Nonmydriatic, modified Davis grading, fundus photo — 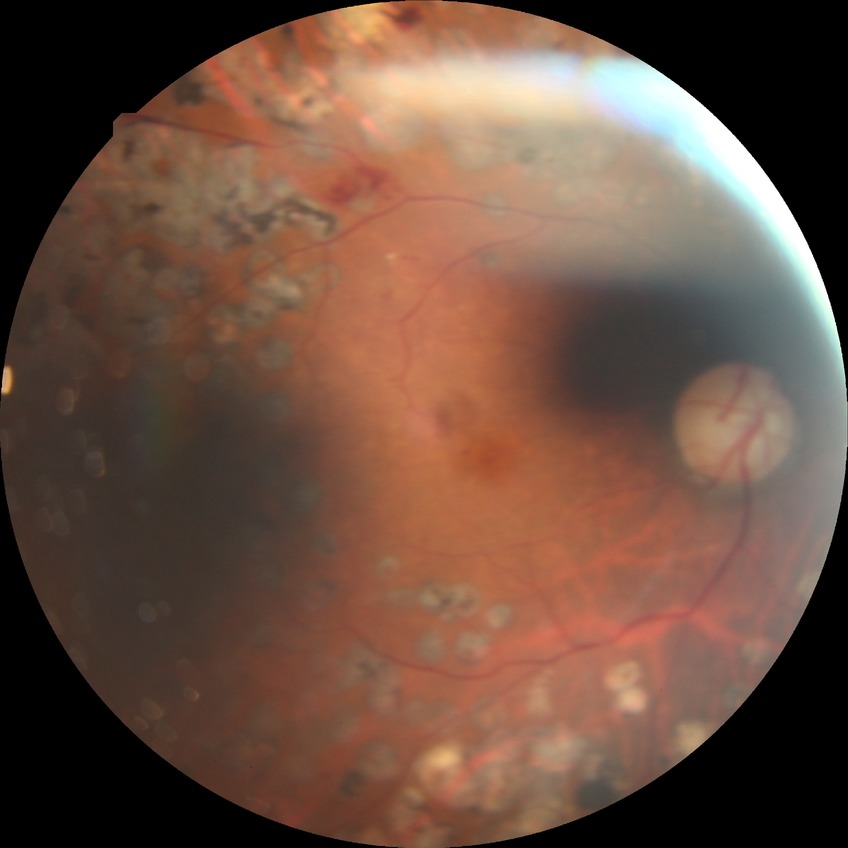

Retinopathy grade: proliferative diabetic retinopathy.